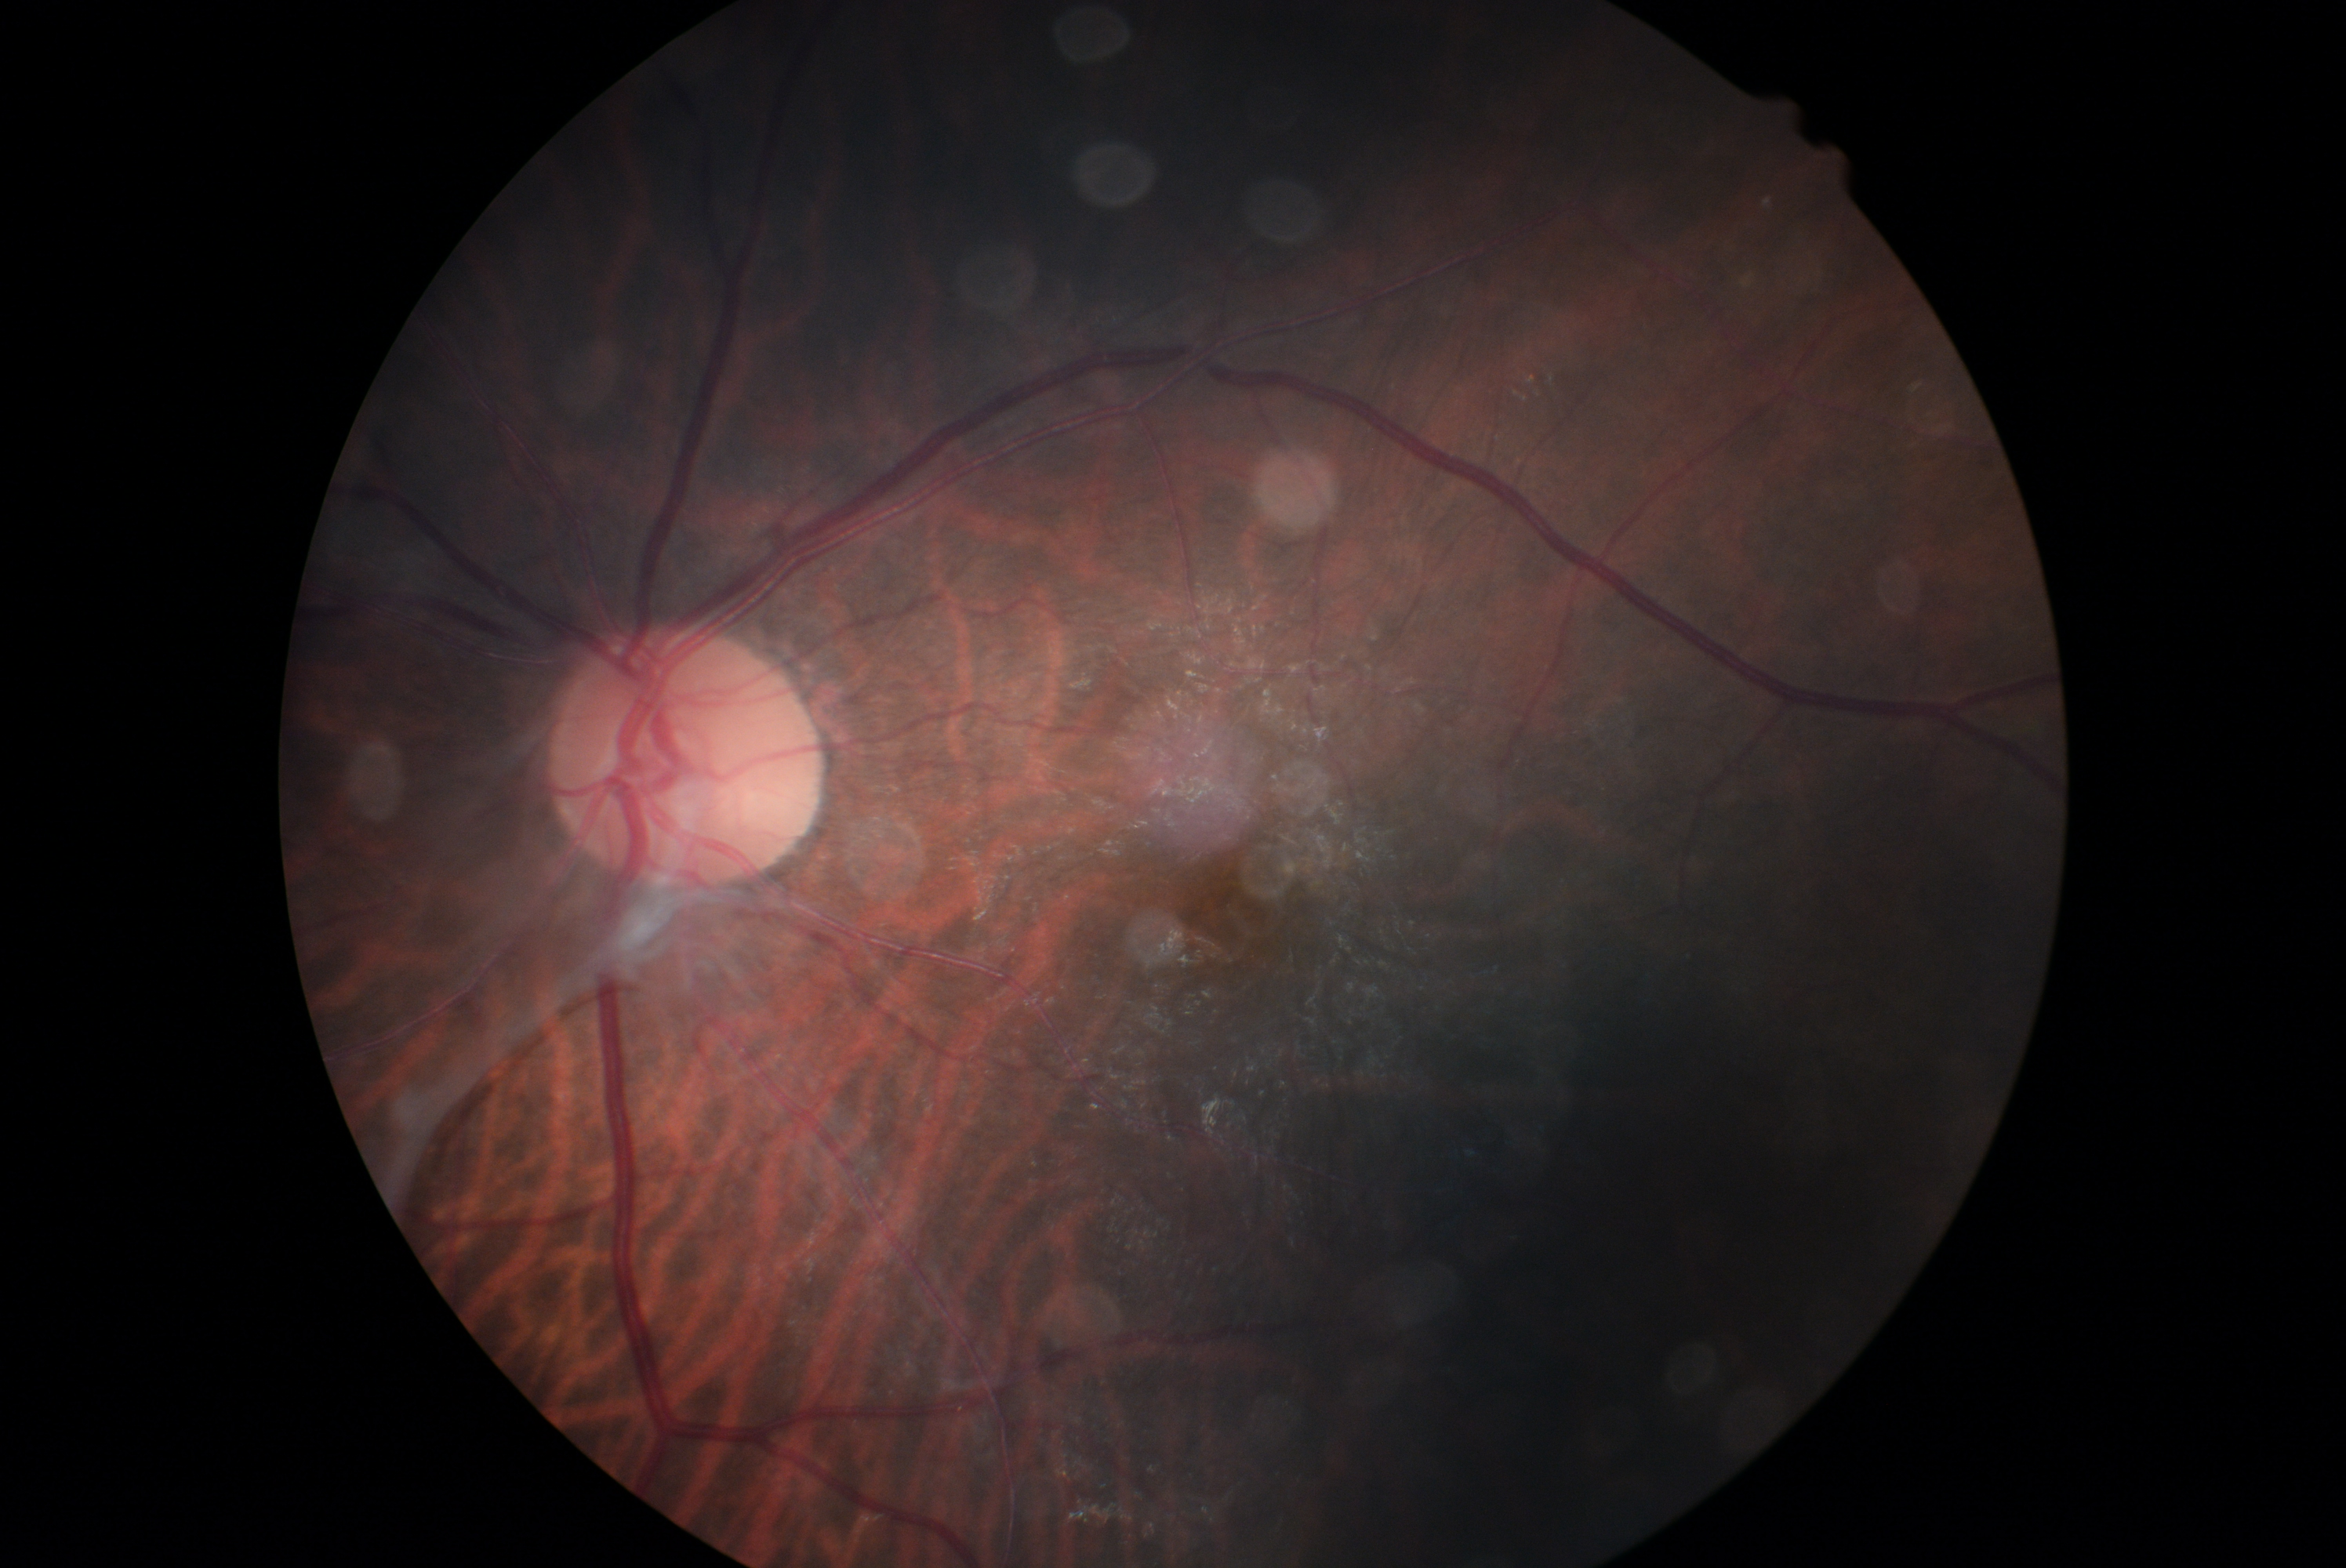

diabetic retinopathy severity: grade 4 (PDR).